Captured with the Phoenix ICON (100° field of view) · Phoenix ICON wide-field infant fundus image · 1240 x 1240 pixels — 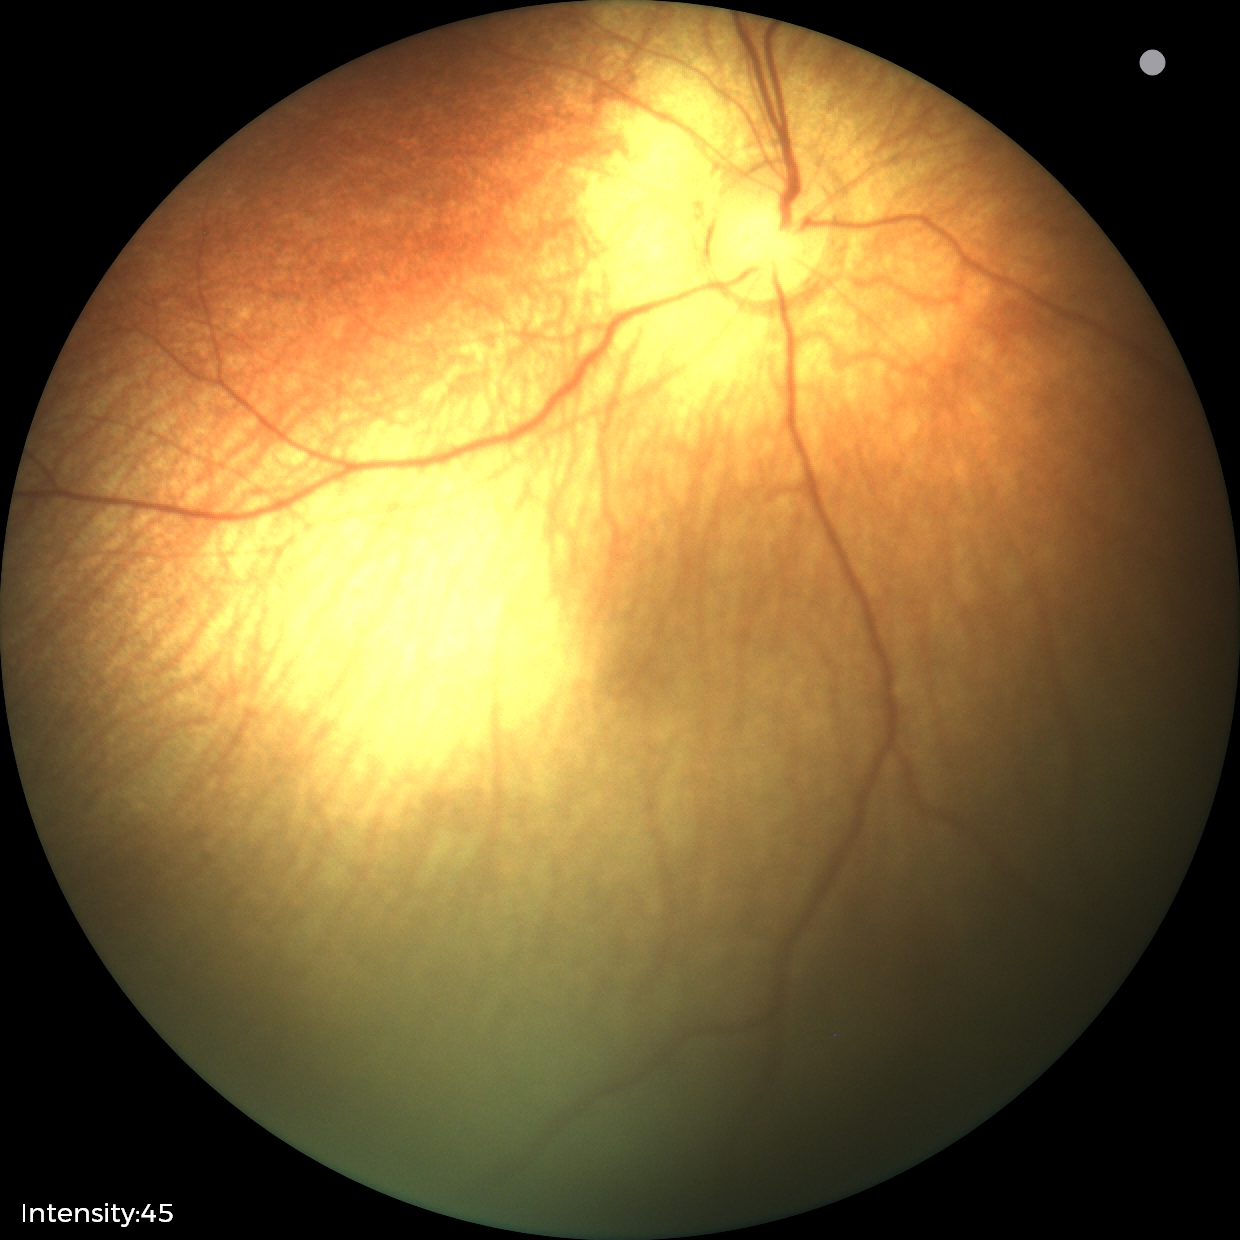
Assessment = no pathology identified.